NIDEK AFC-230, 45 degree fundus photograph, image size 848x848: 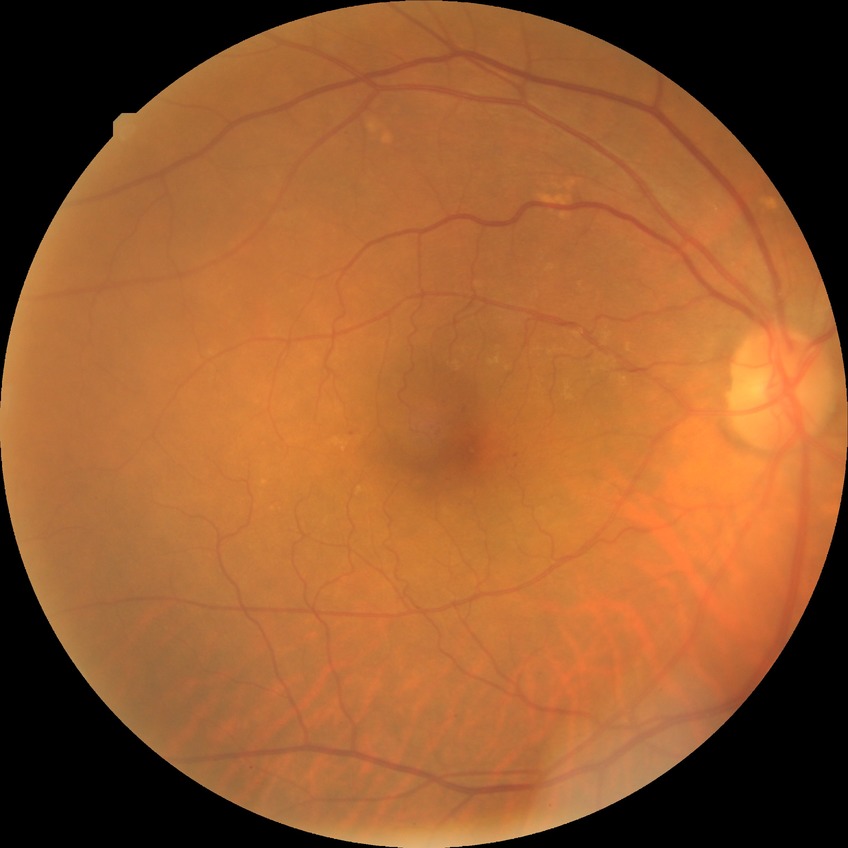
Diabetic retinopathy (DR) is simple diabetic retinopathy (SDR).